Wide-field contact fundus photograph of an infant; 1440 by 1080 pixels.
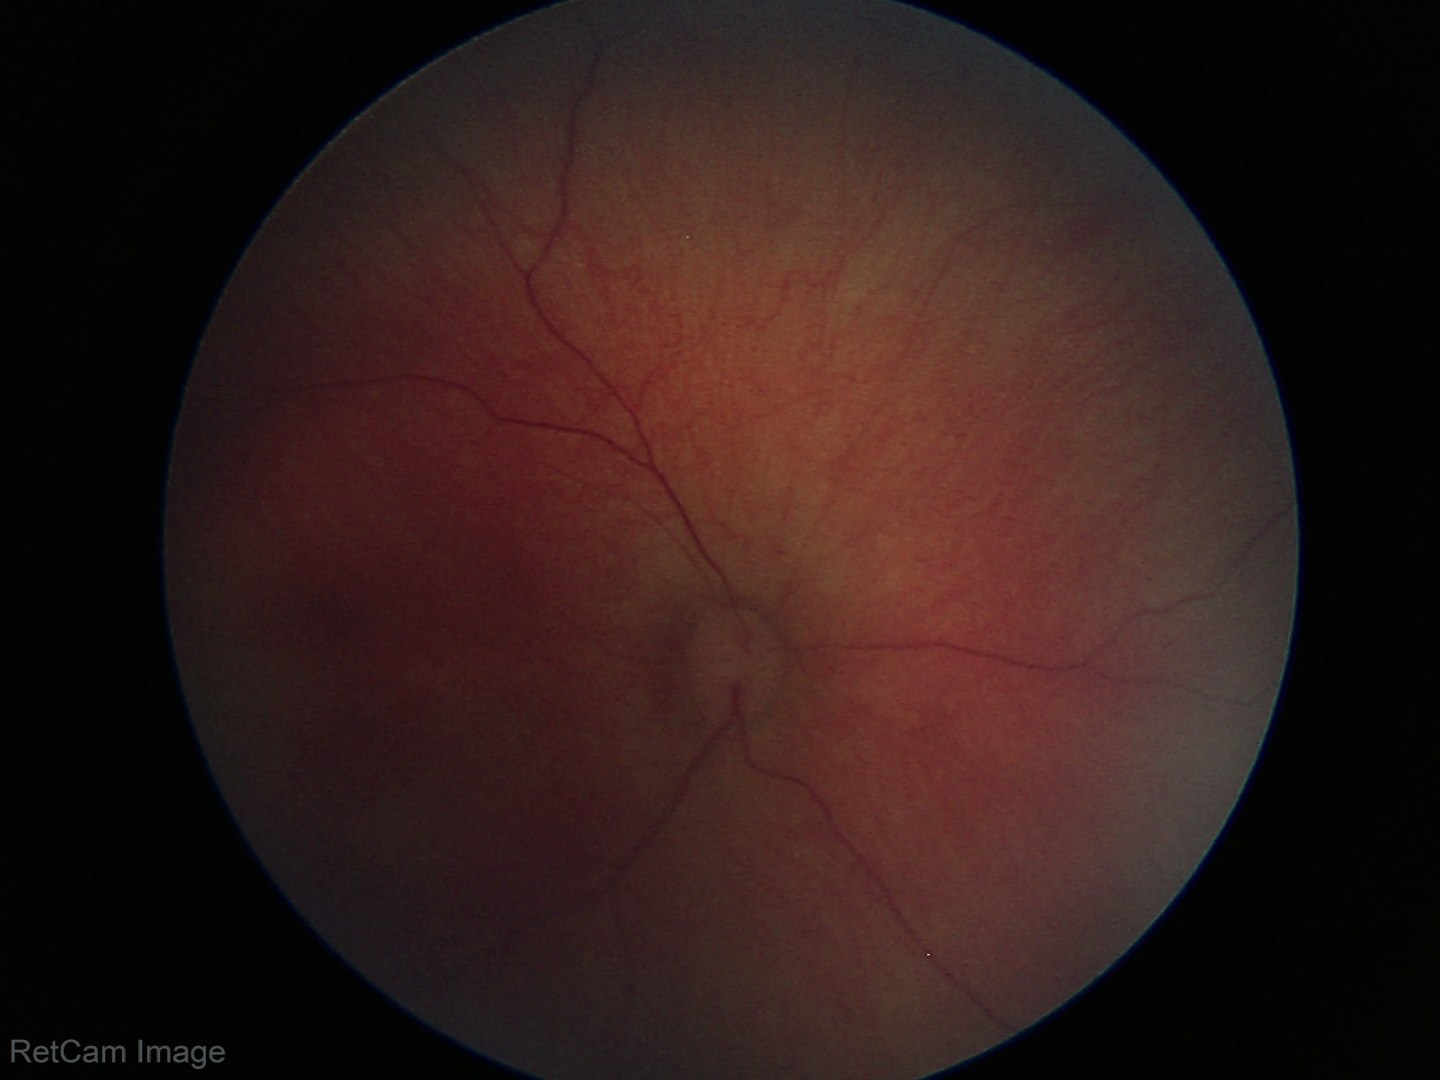
Diagnosis = physiological appearance.